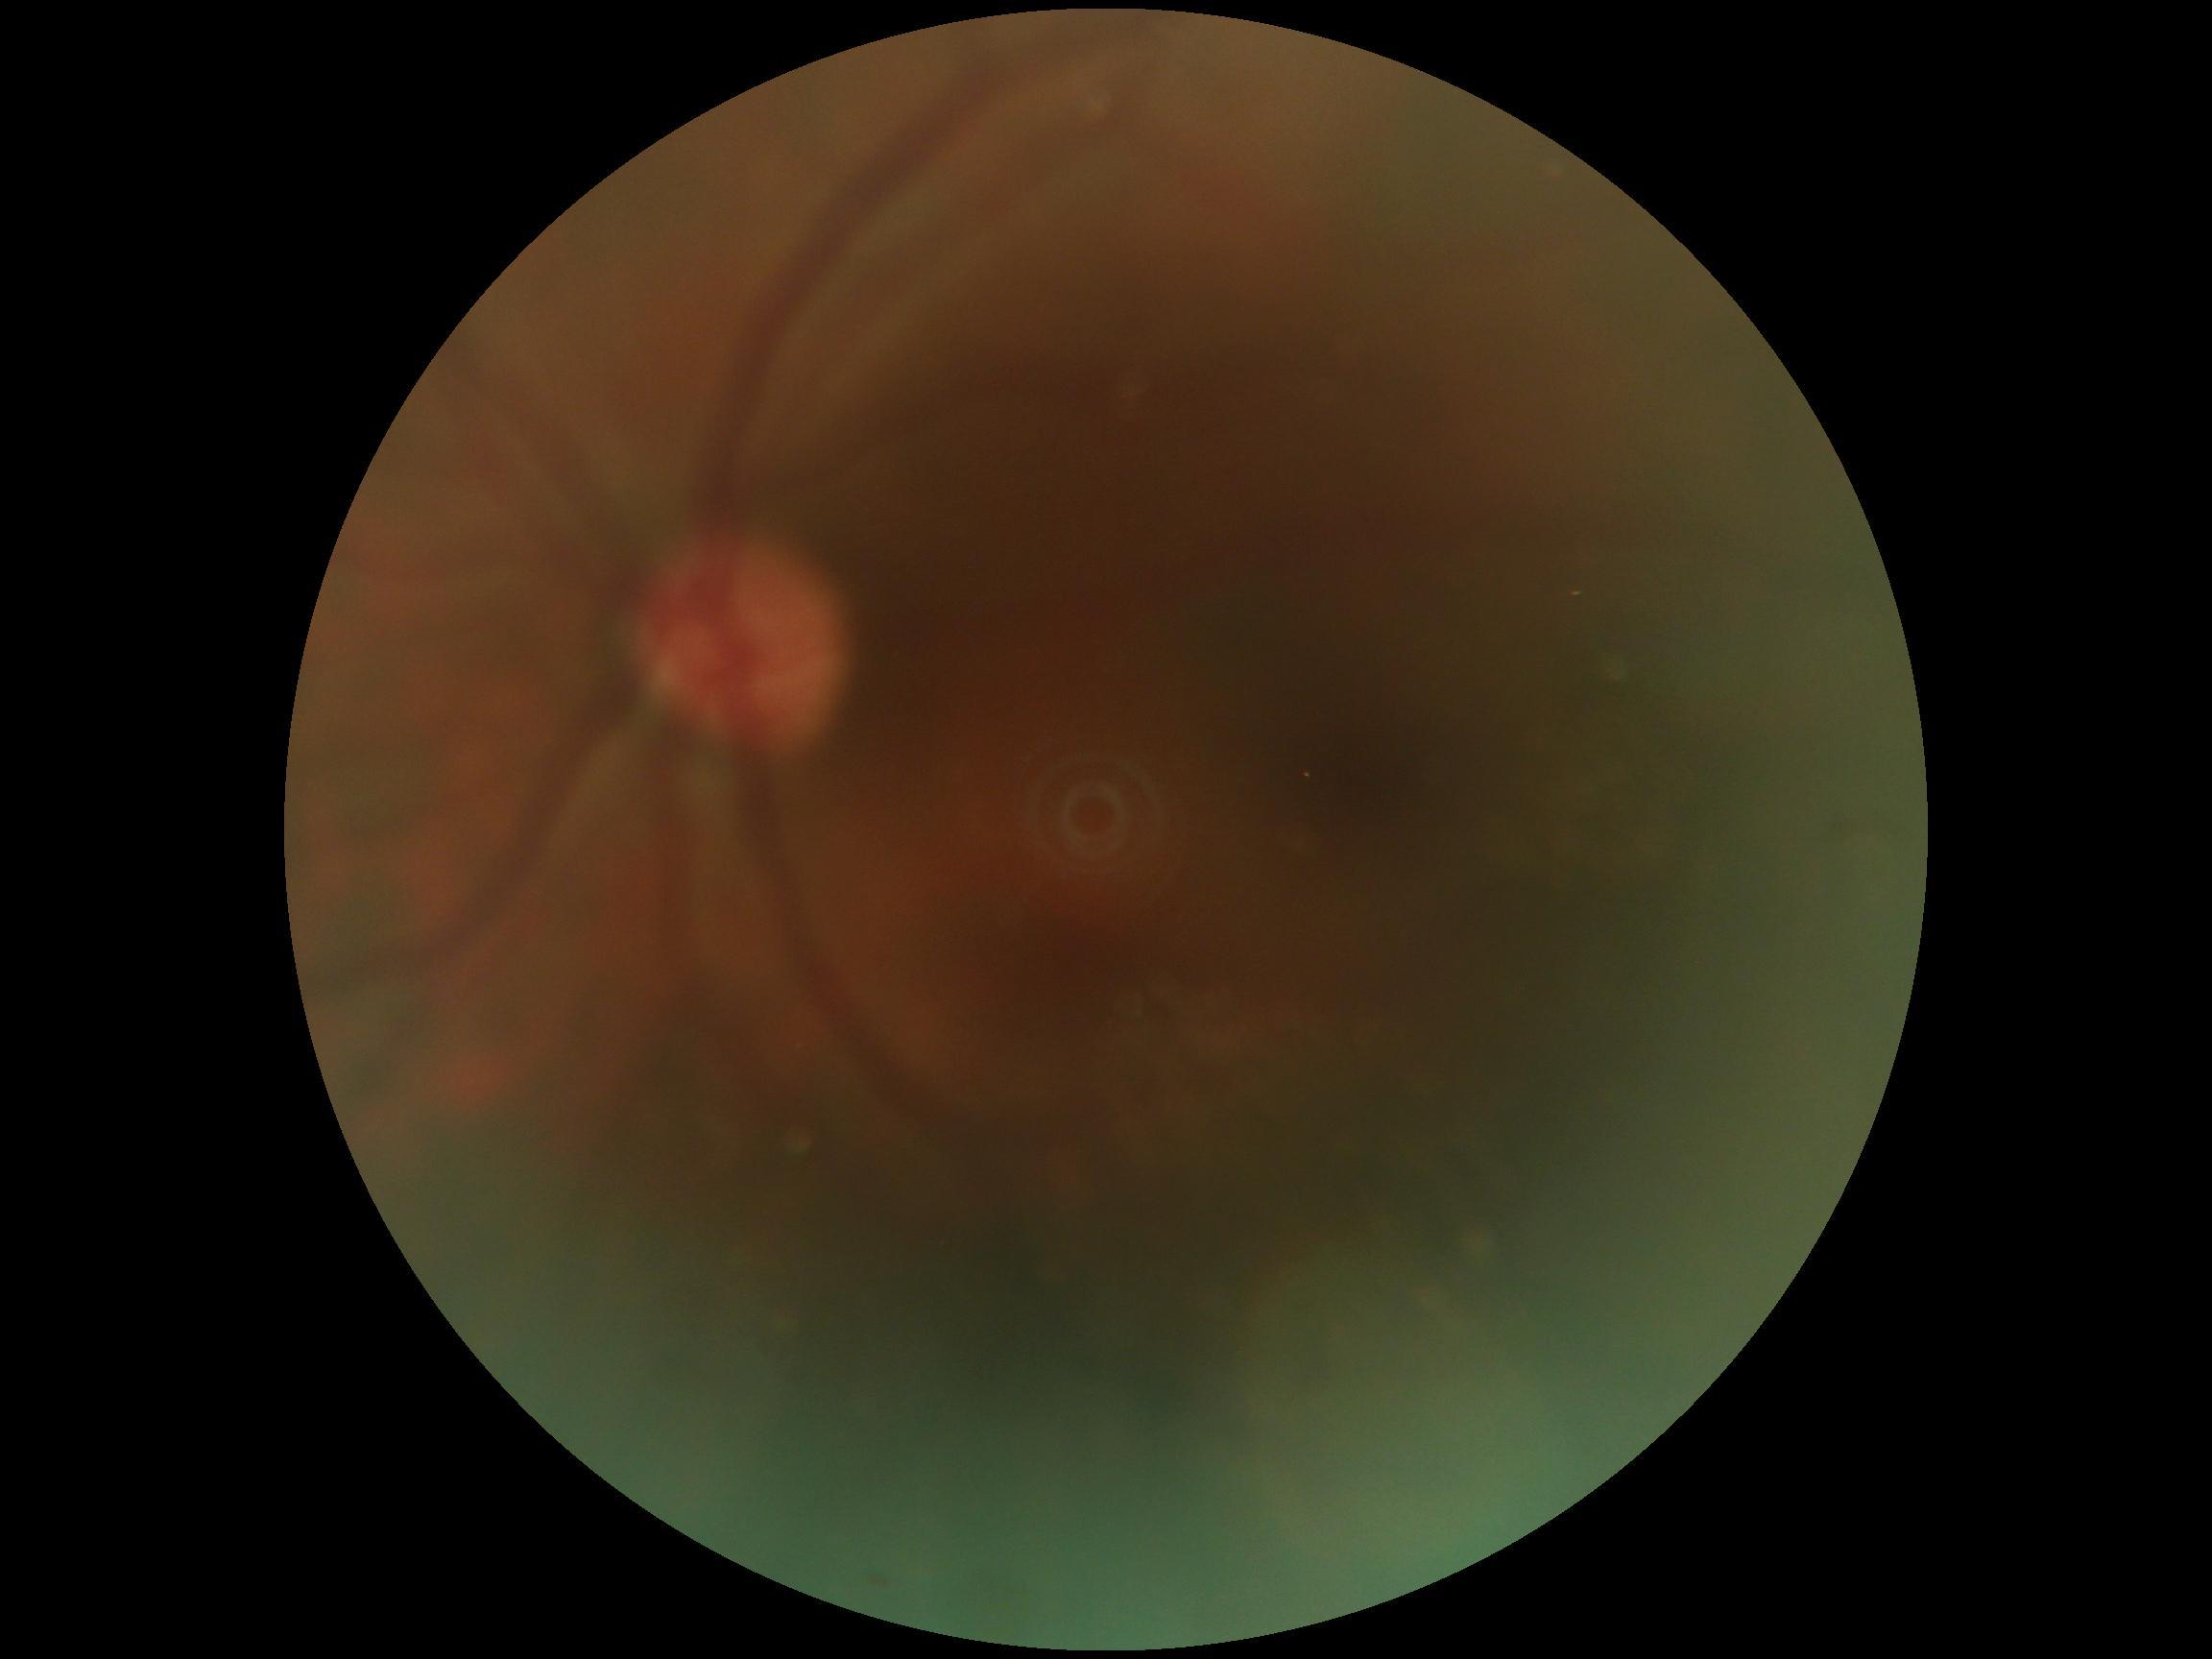
Quality too poor to assess for DR. Diabetic retinopathy severity is ungradable.